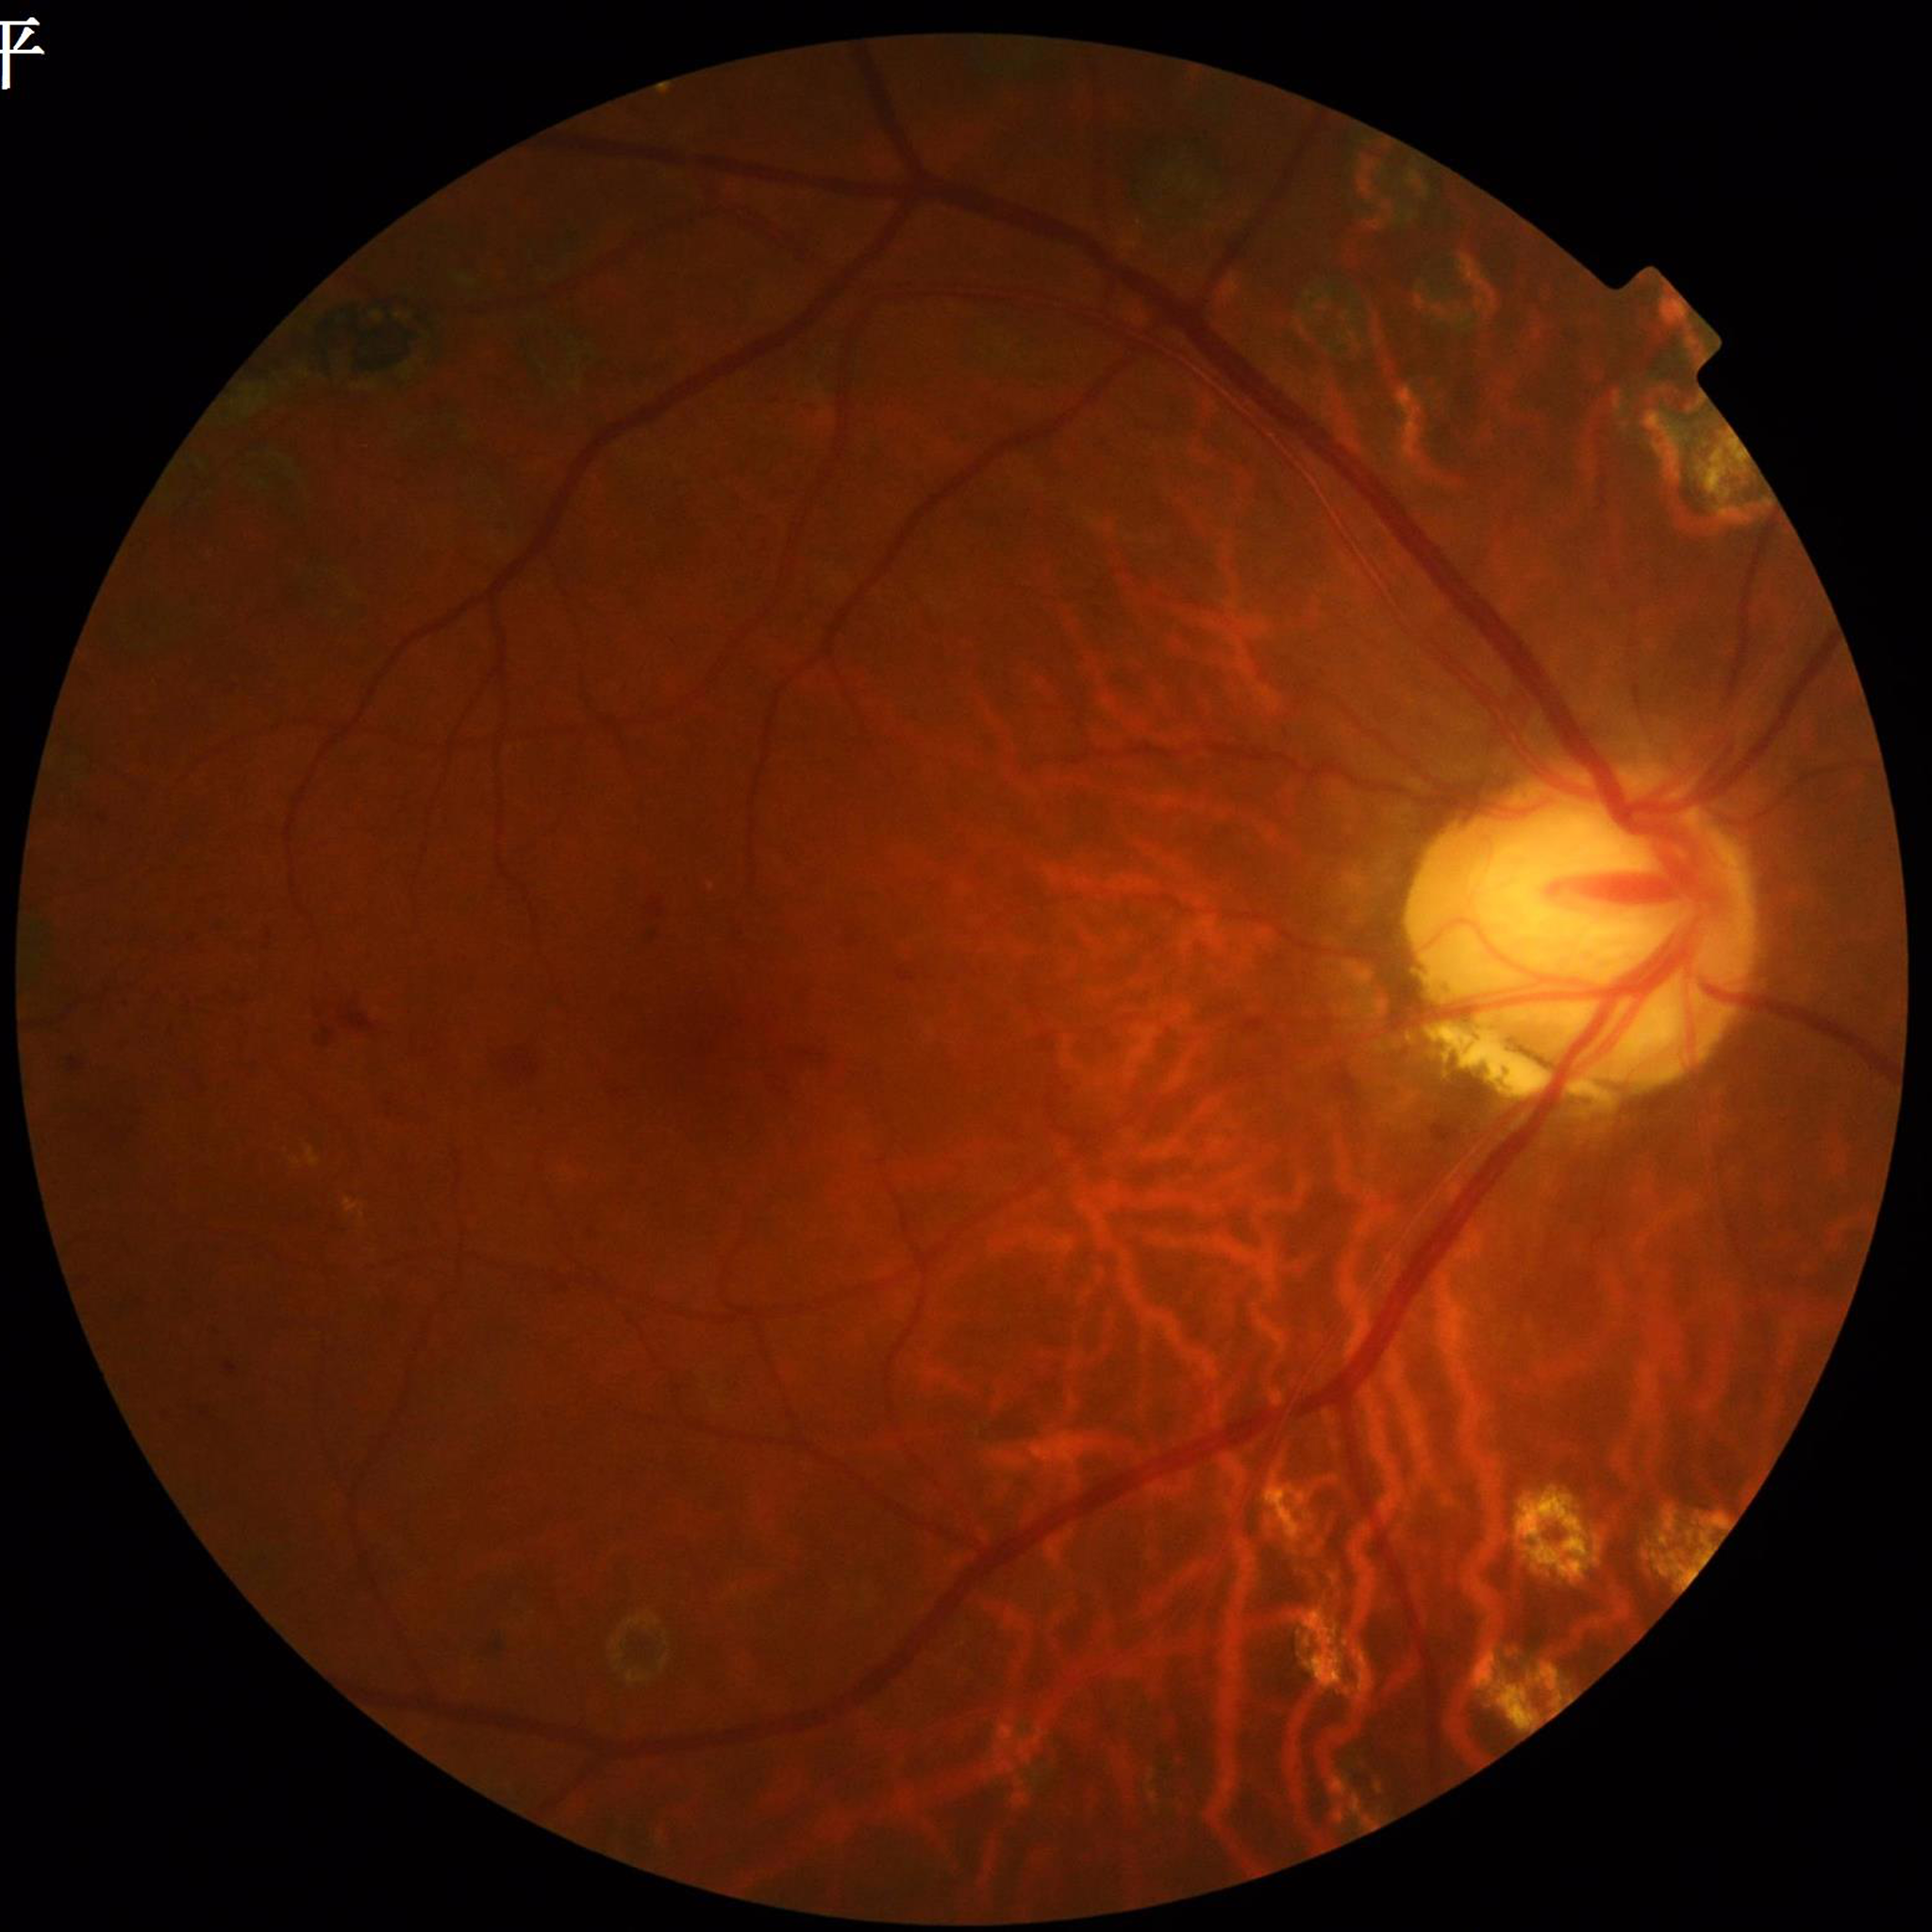
Clinical diagnosis: DR